2048x1536px:
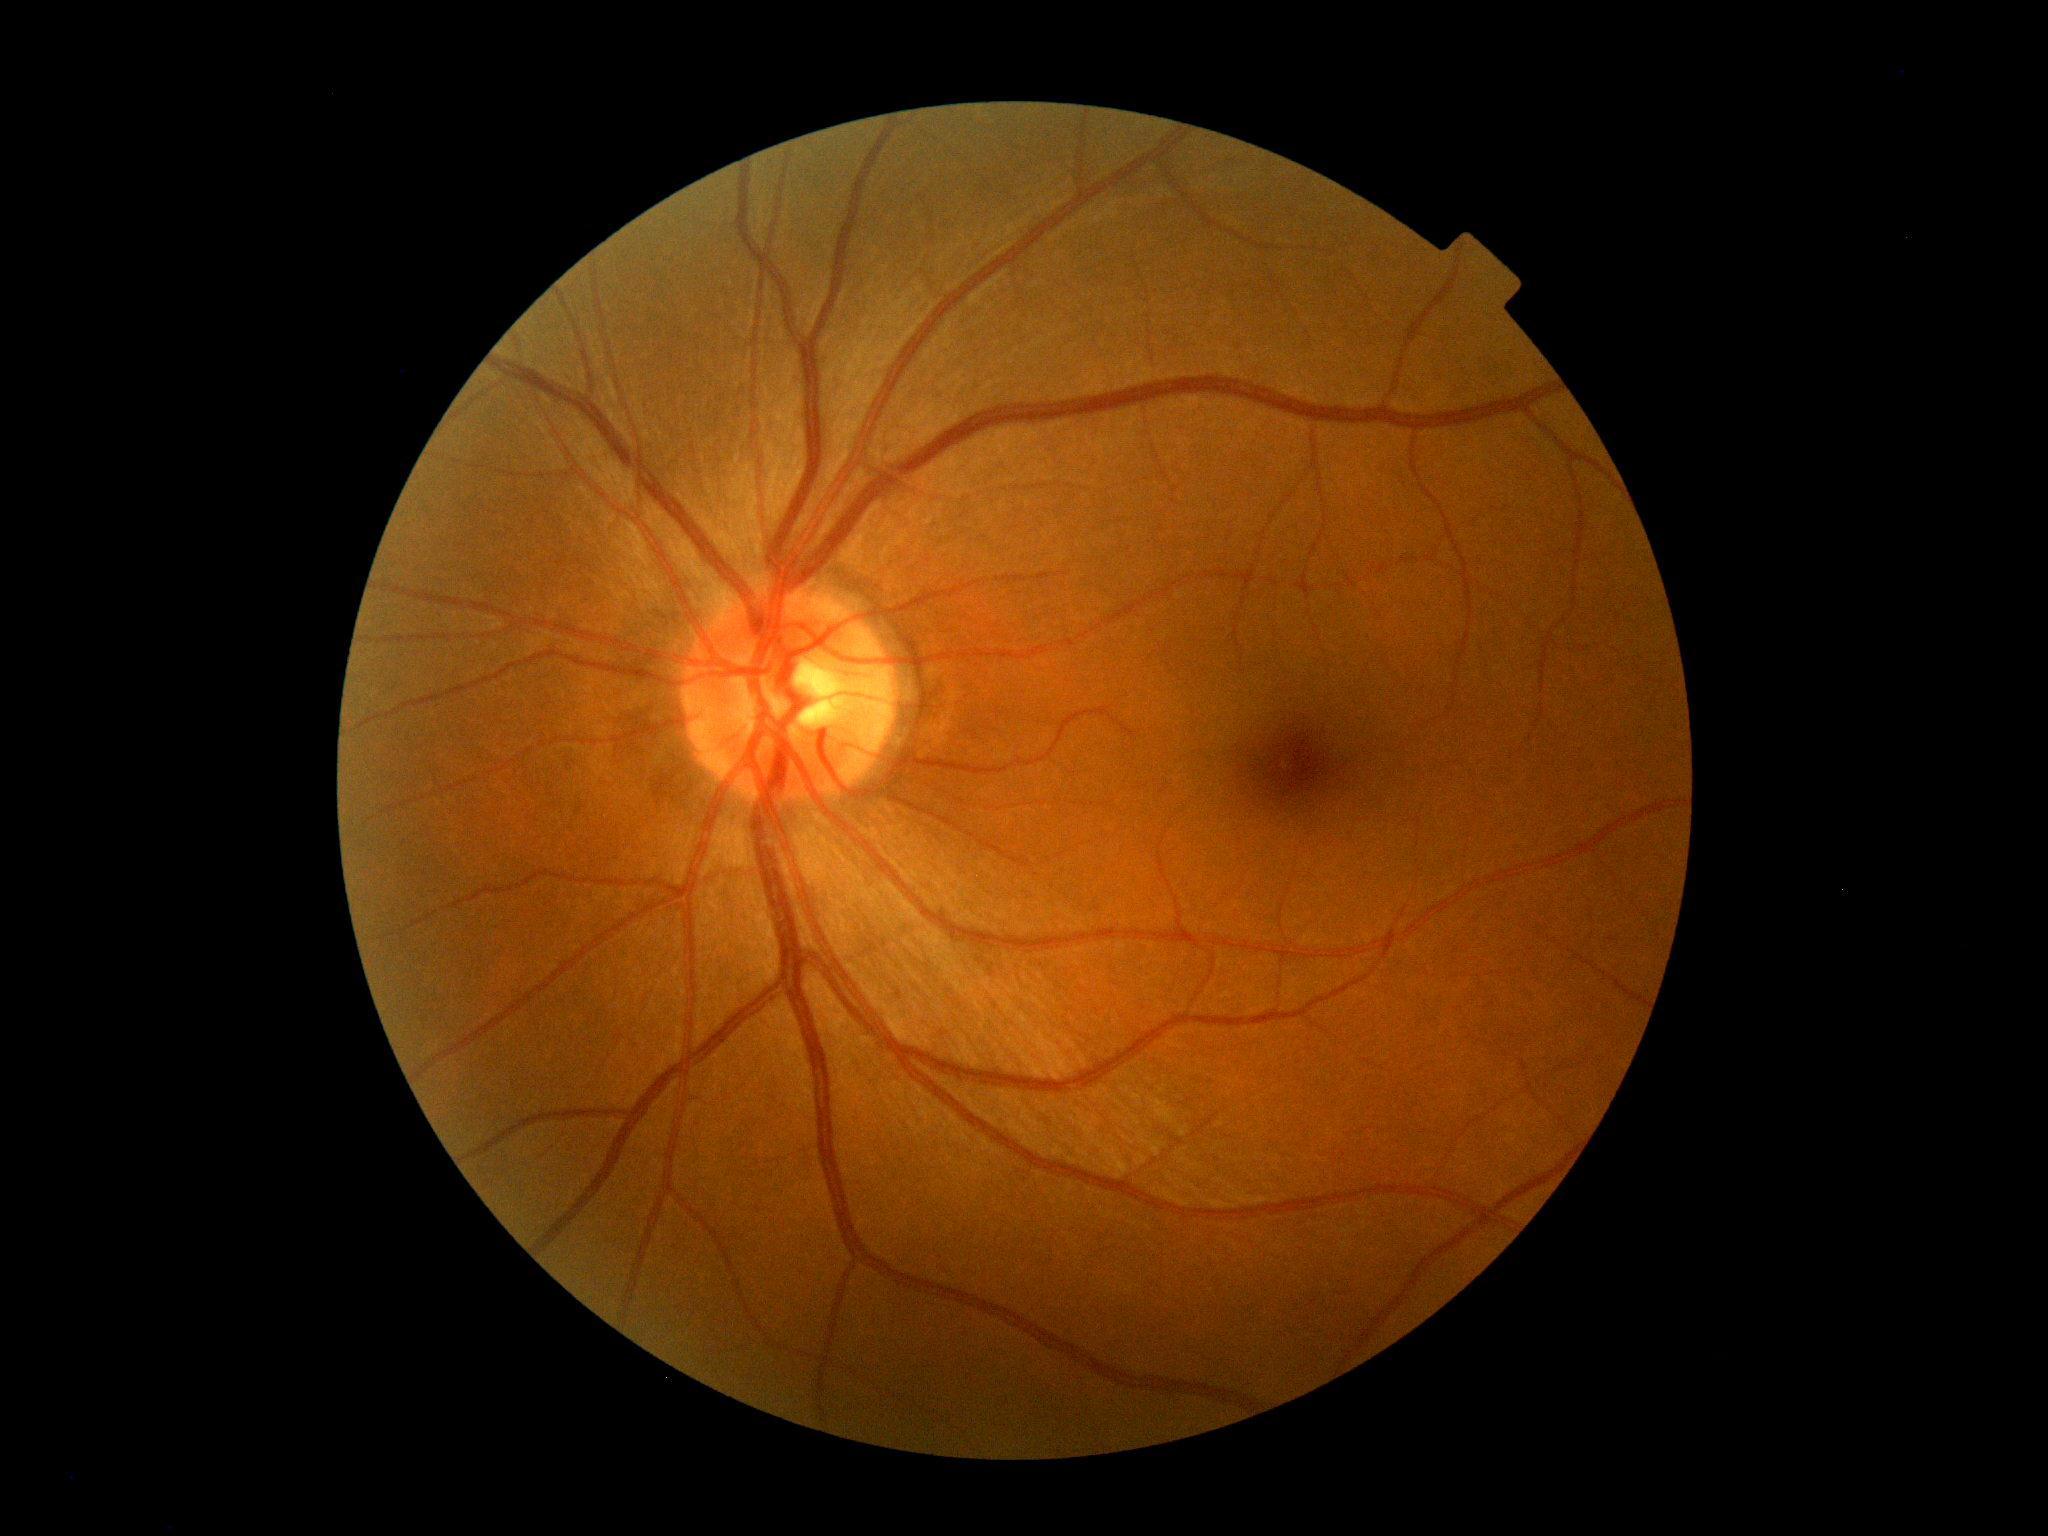
No signs of diabetic retinopathy. DR stage: grade 0 — no visible signs of diabetic retinopathy.